Captured with the Phoenix ICON (100° field of view) · Phoenix ICON wide-field infant fundus image · 1240x1240.
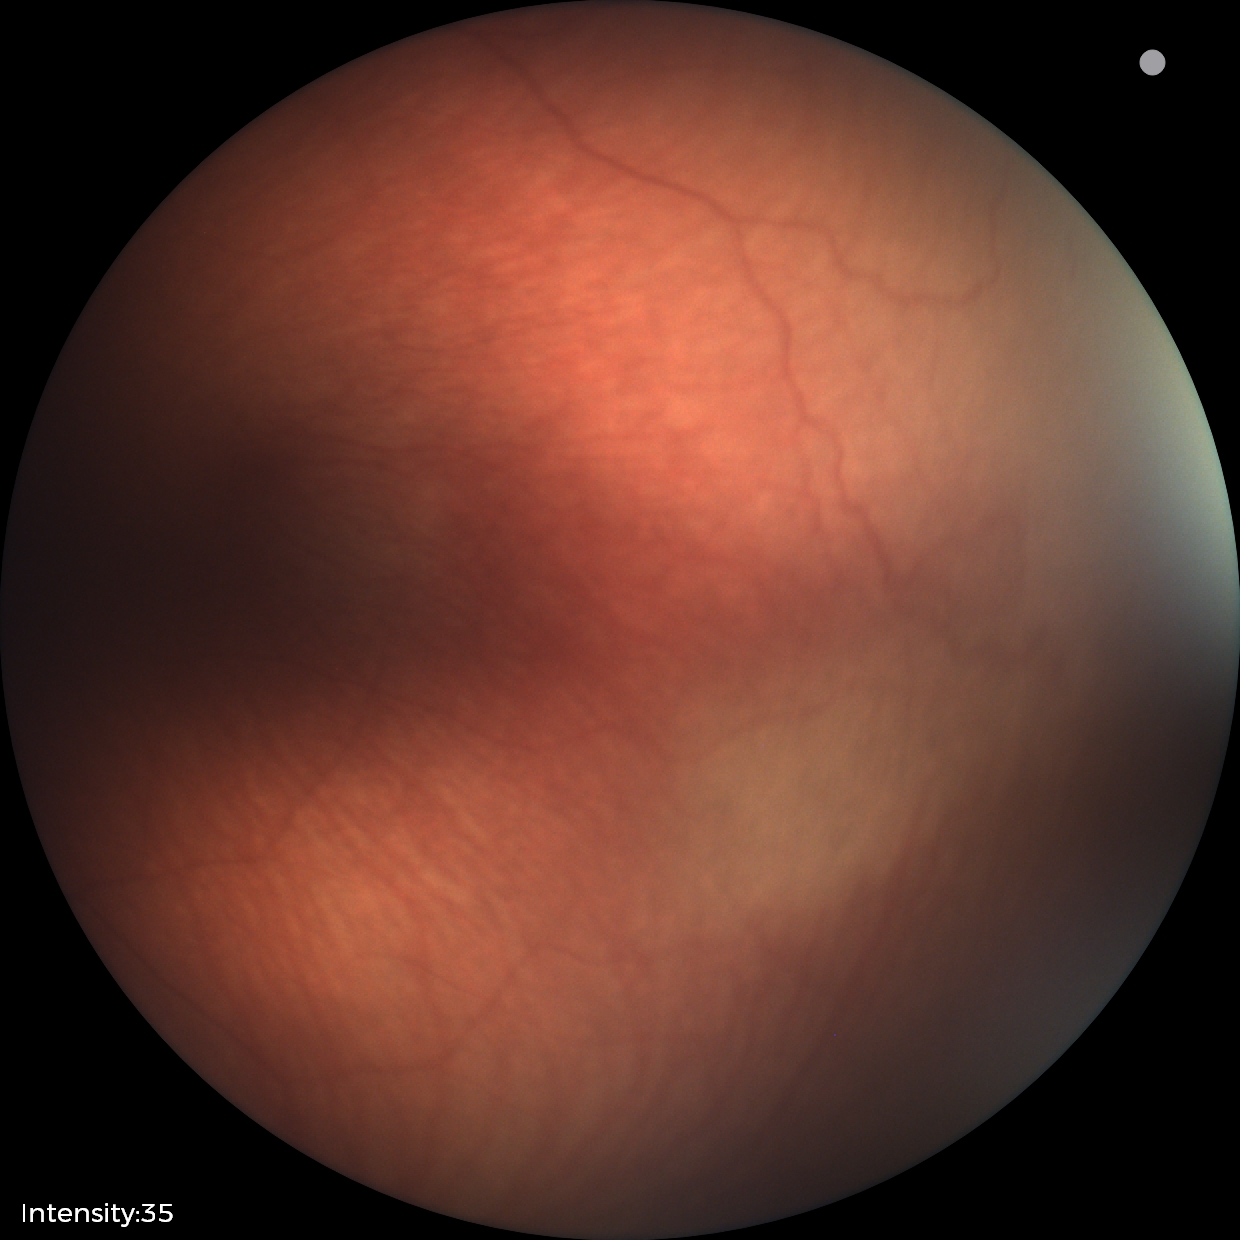 Screening examination with no abnormal retinal findings.